NIDEK AFC-230 · CFP · without pupil dilation · 45-degree field of view
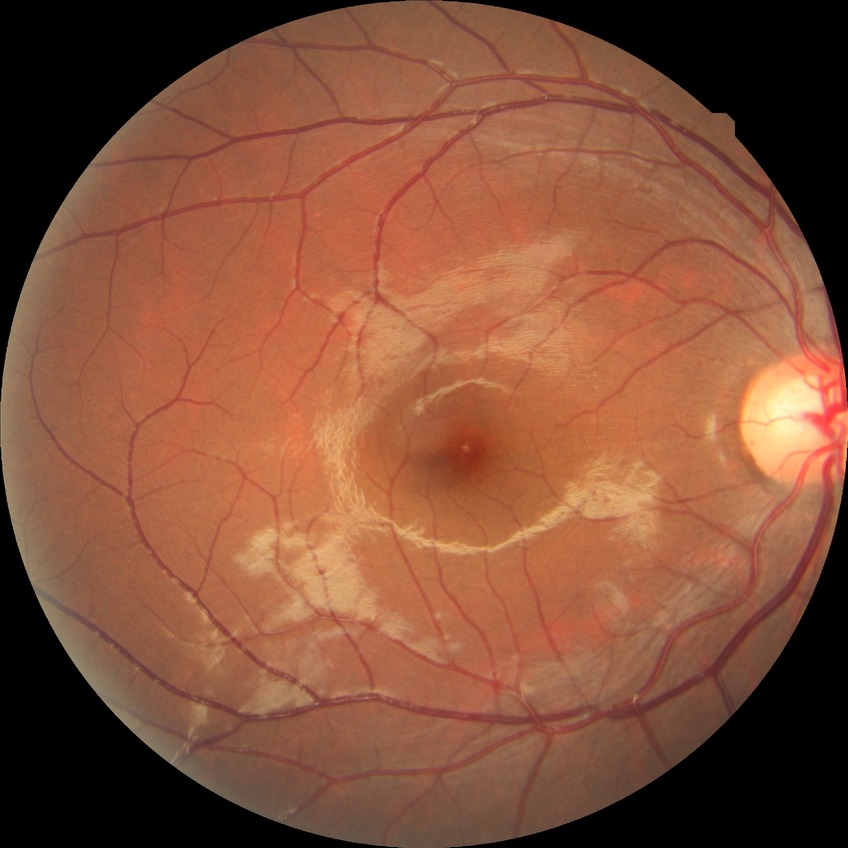 Diabetic retinopathy (DR): no diabetic retinopathy (NDR).